Modified Davis grading.
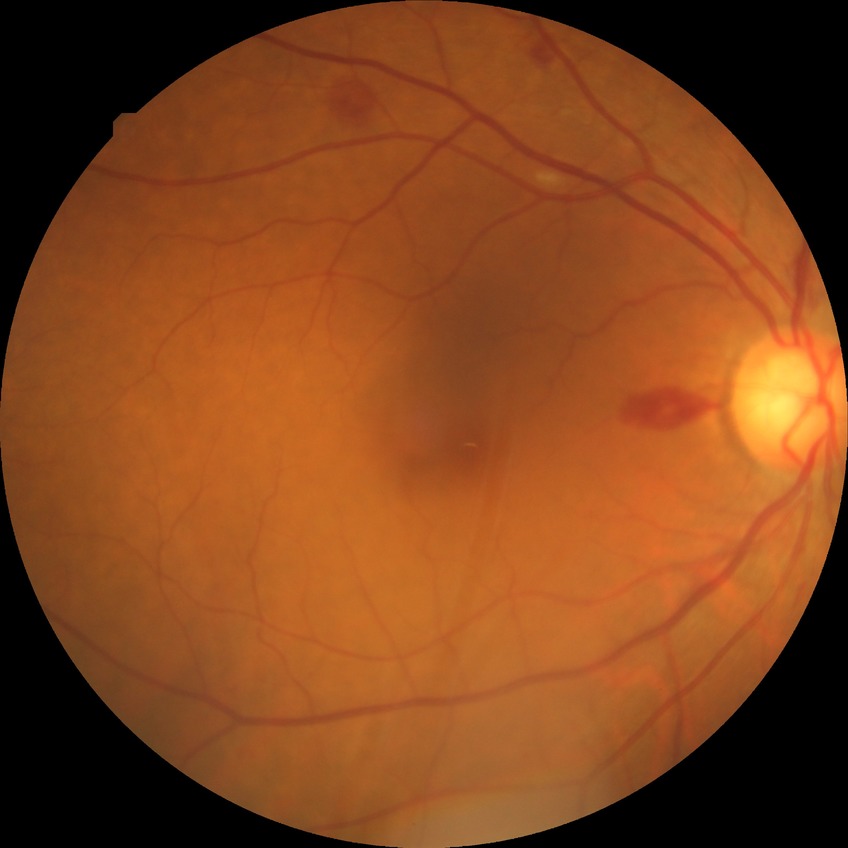 Disease class: non-proliferative diabetic retinopathy.
Diabetic retinopathy (DR) is simple diabetic retinopathy (SDR).